Color fundus photograph; 2352 by 1568 pixels; 45° field of view:
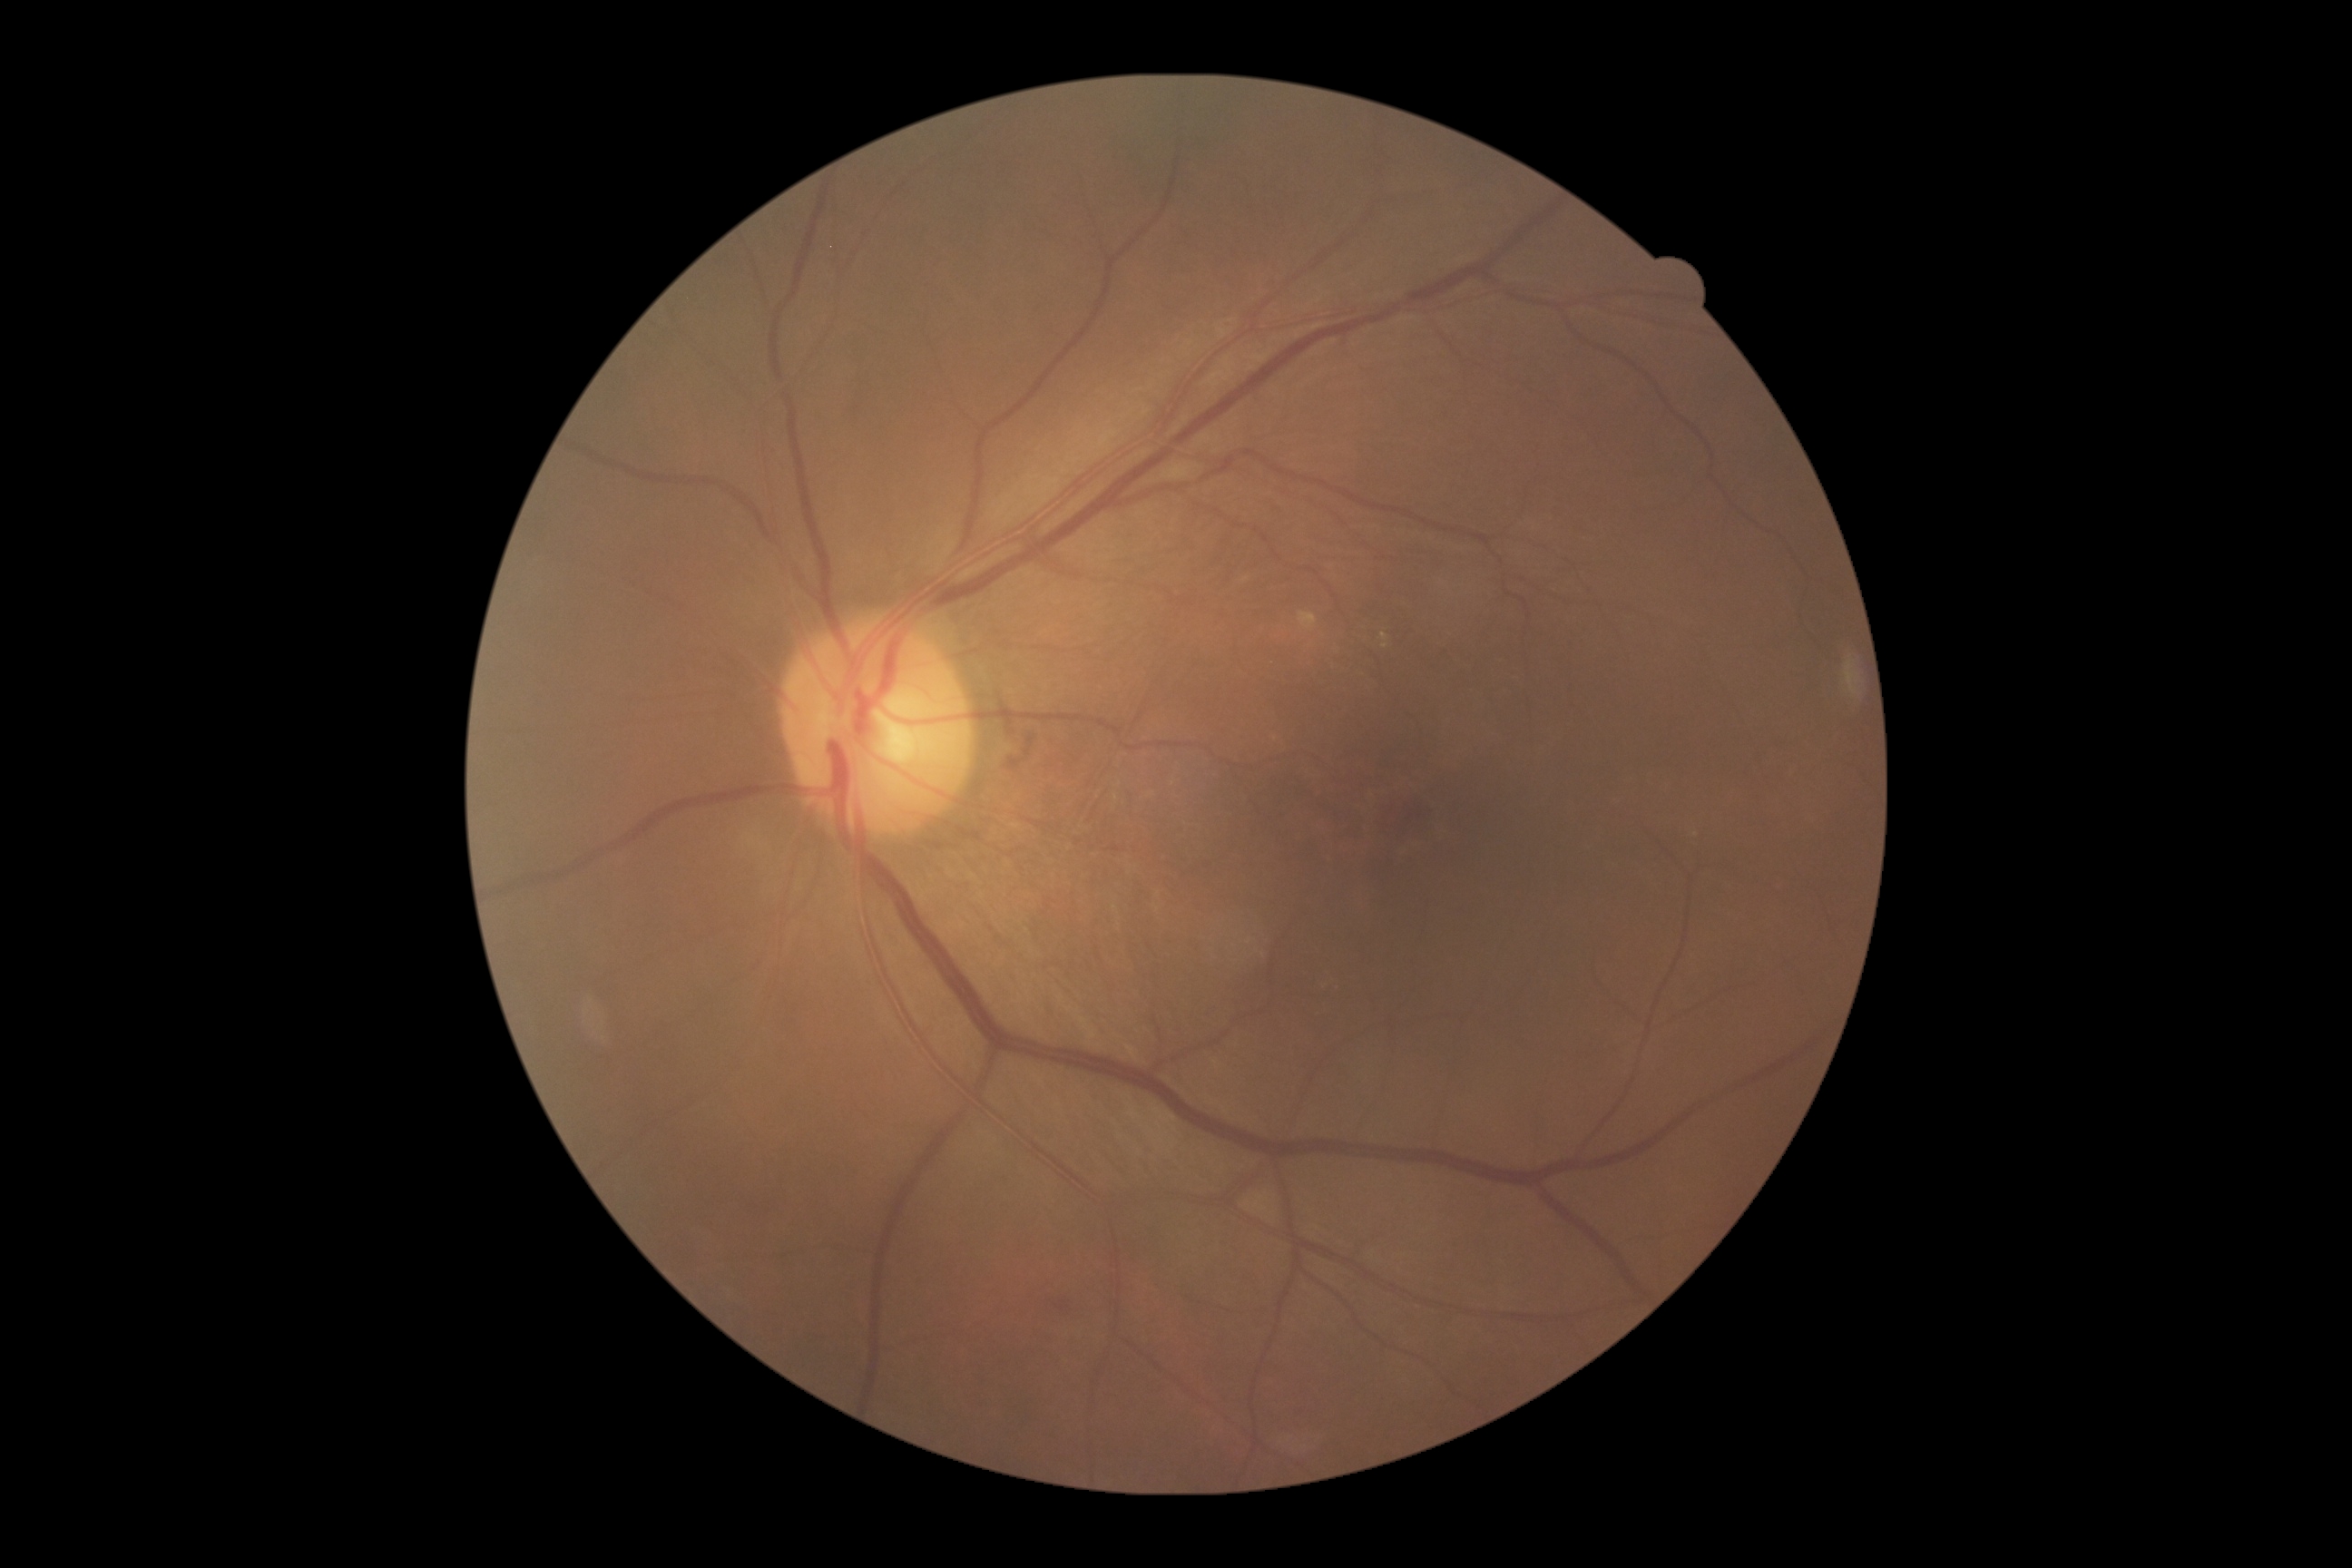 Diabetic retinopathy (DR) is moderate non-proliferative diabetic retinopathy (grade 2)
microaneurysms (MAs): none
hemorrhages (HEs): {"x1": 1055, "y1": 1300, "x2": 1070, "y2": 1311}
soft exudates (SEs): none
hard exudates (EXs): {"x1": 1380, "y1": 632, "x2": 1389, "y2": 649}
Smaller EXs around (1697, 836)